Phoenix ICON wide-field infant fundus image; 1240 x 1240 pixels; Phoenix ICON, 100° FOV:
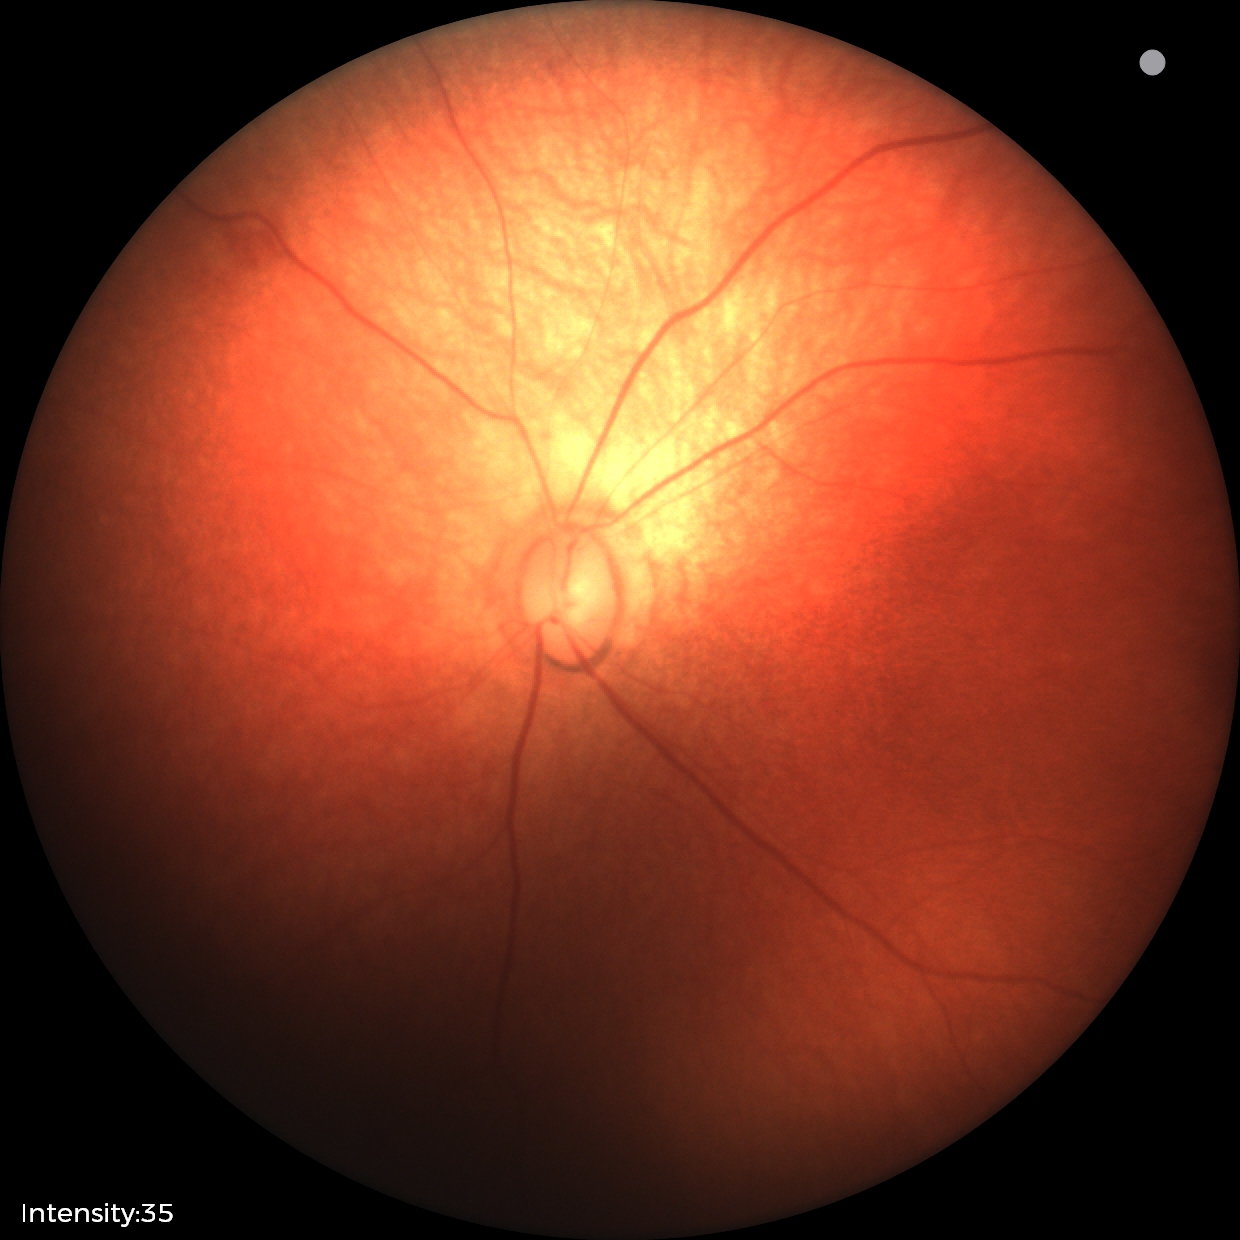
Screening examination diagnosed as physiological.